Modified Davis classification, 848 x 848 pixels:
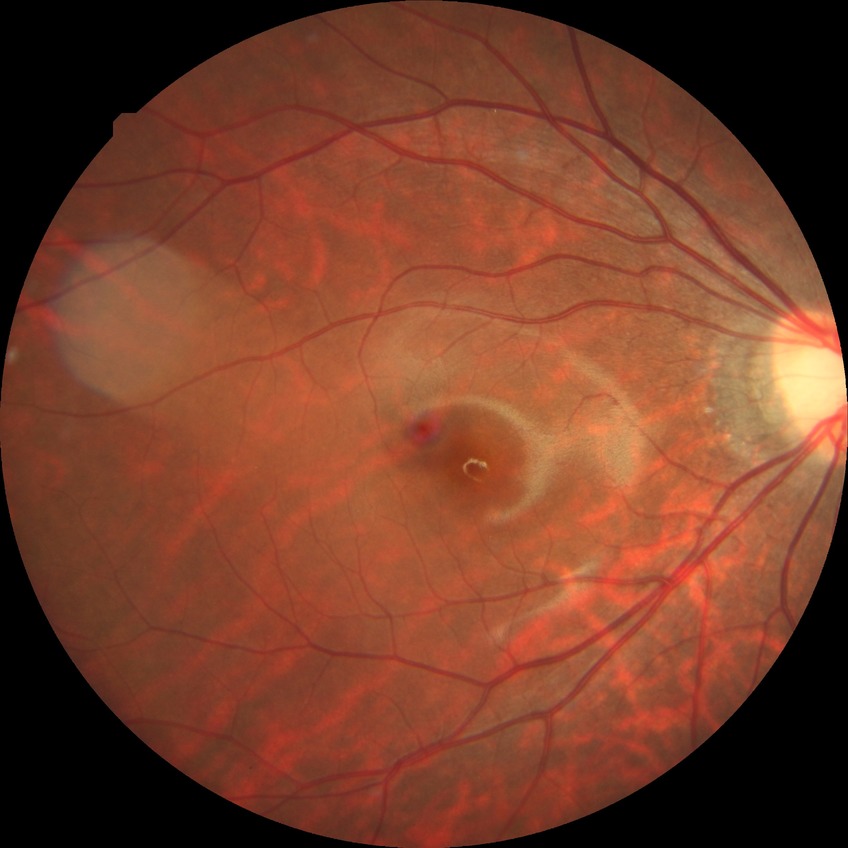 {
  "davis_grade": "NDR"
}